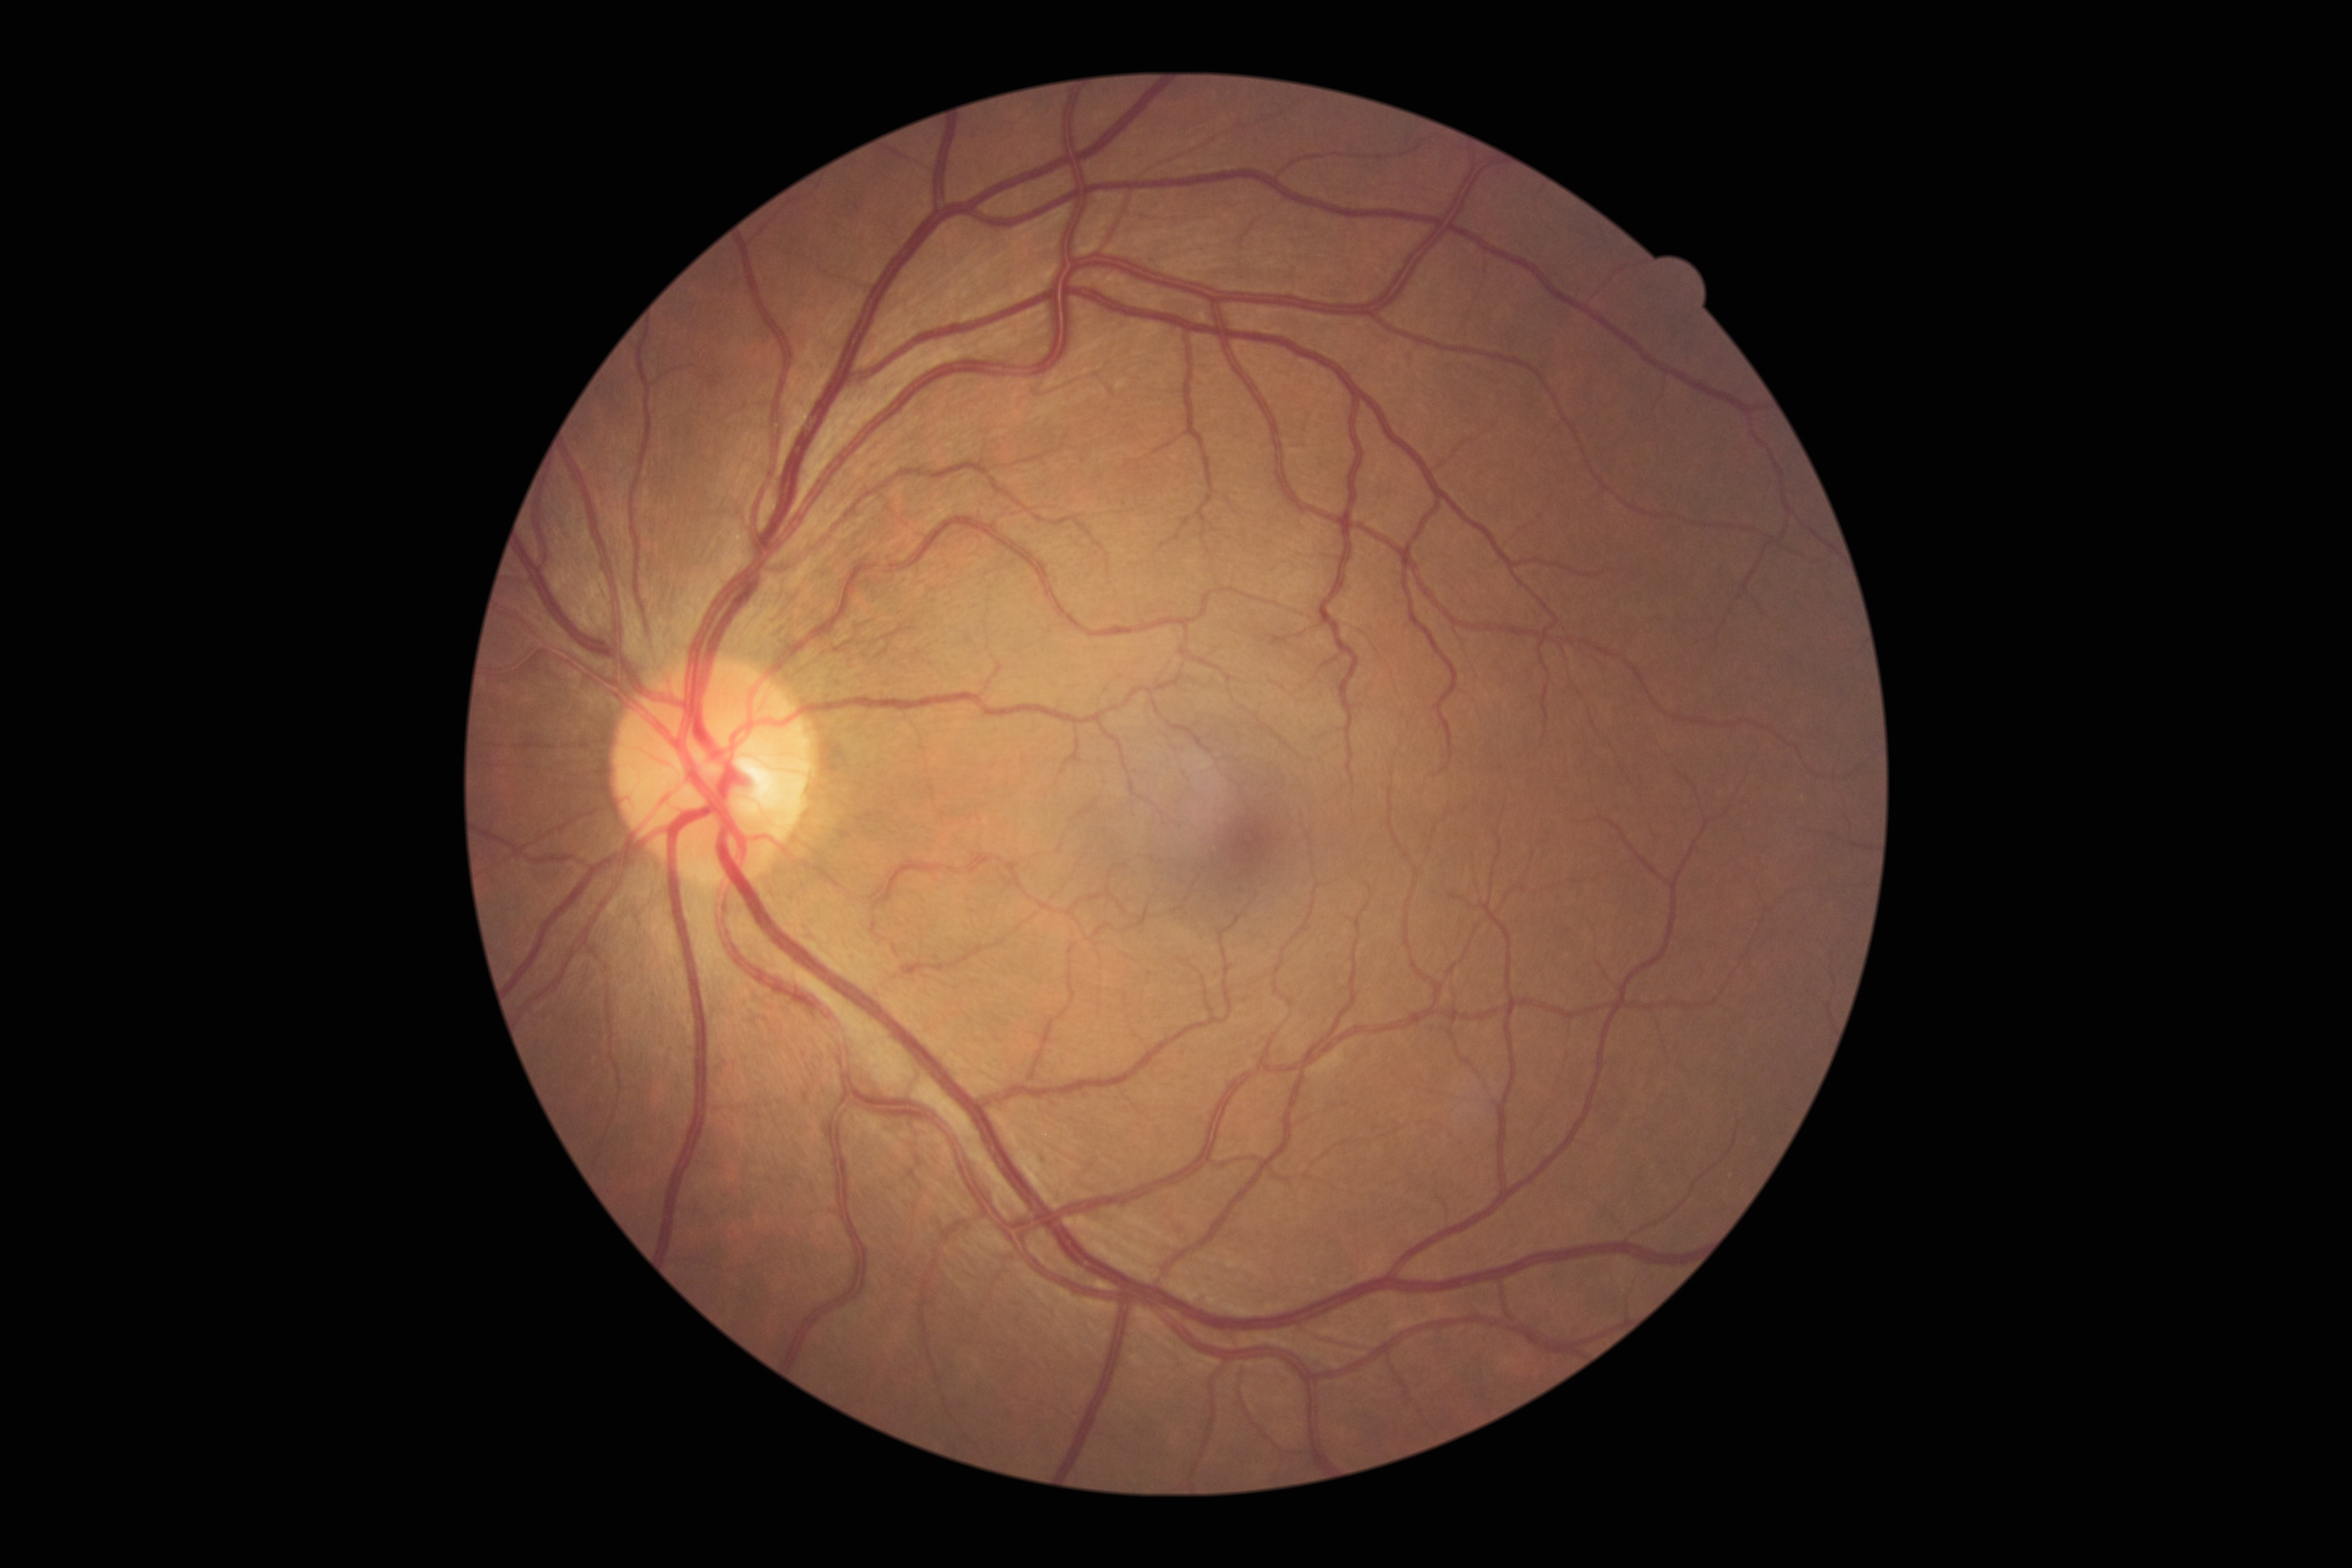 Retinopathy grade is 0.